Pediatric retinal photograph (wide-field)
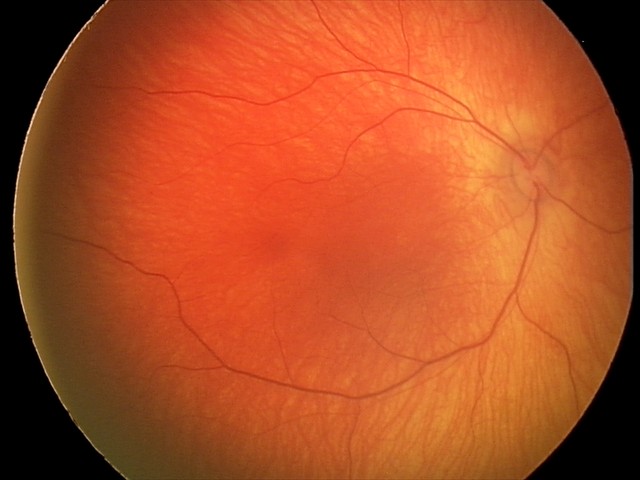 Finding: physiological appearance.